Optic disc at the center of the field. Undilated pupil. Captured on a Topcon TRC-NW400 fundus camera. Color fundus image. 30° FOV. 2212x1661.
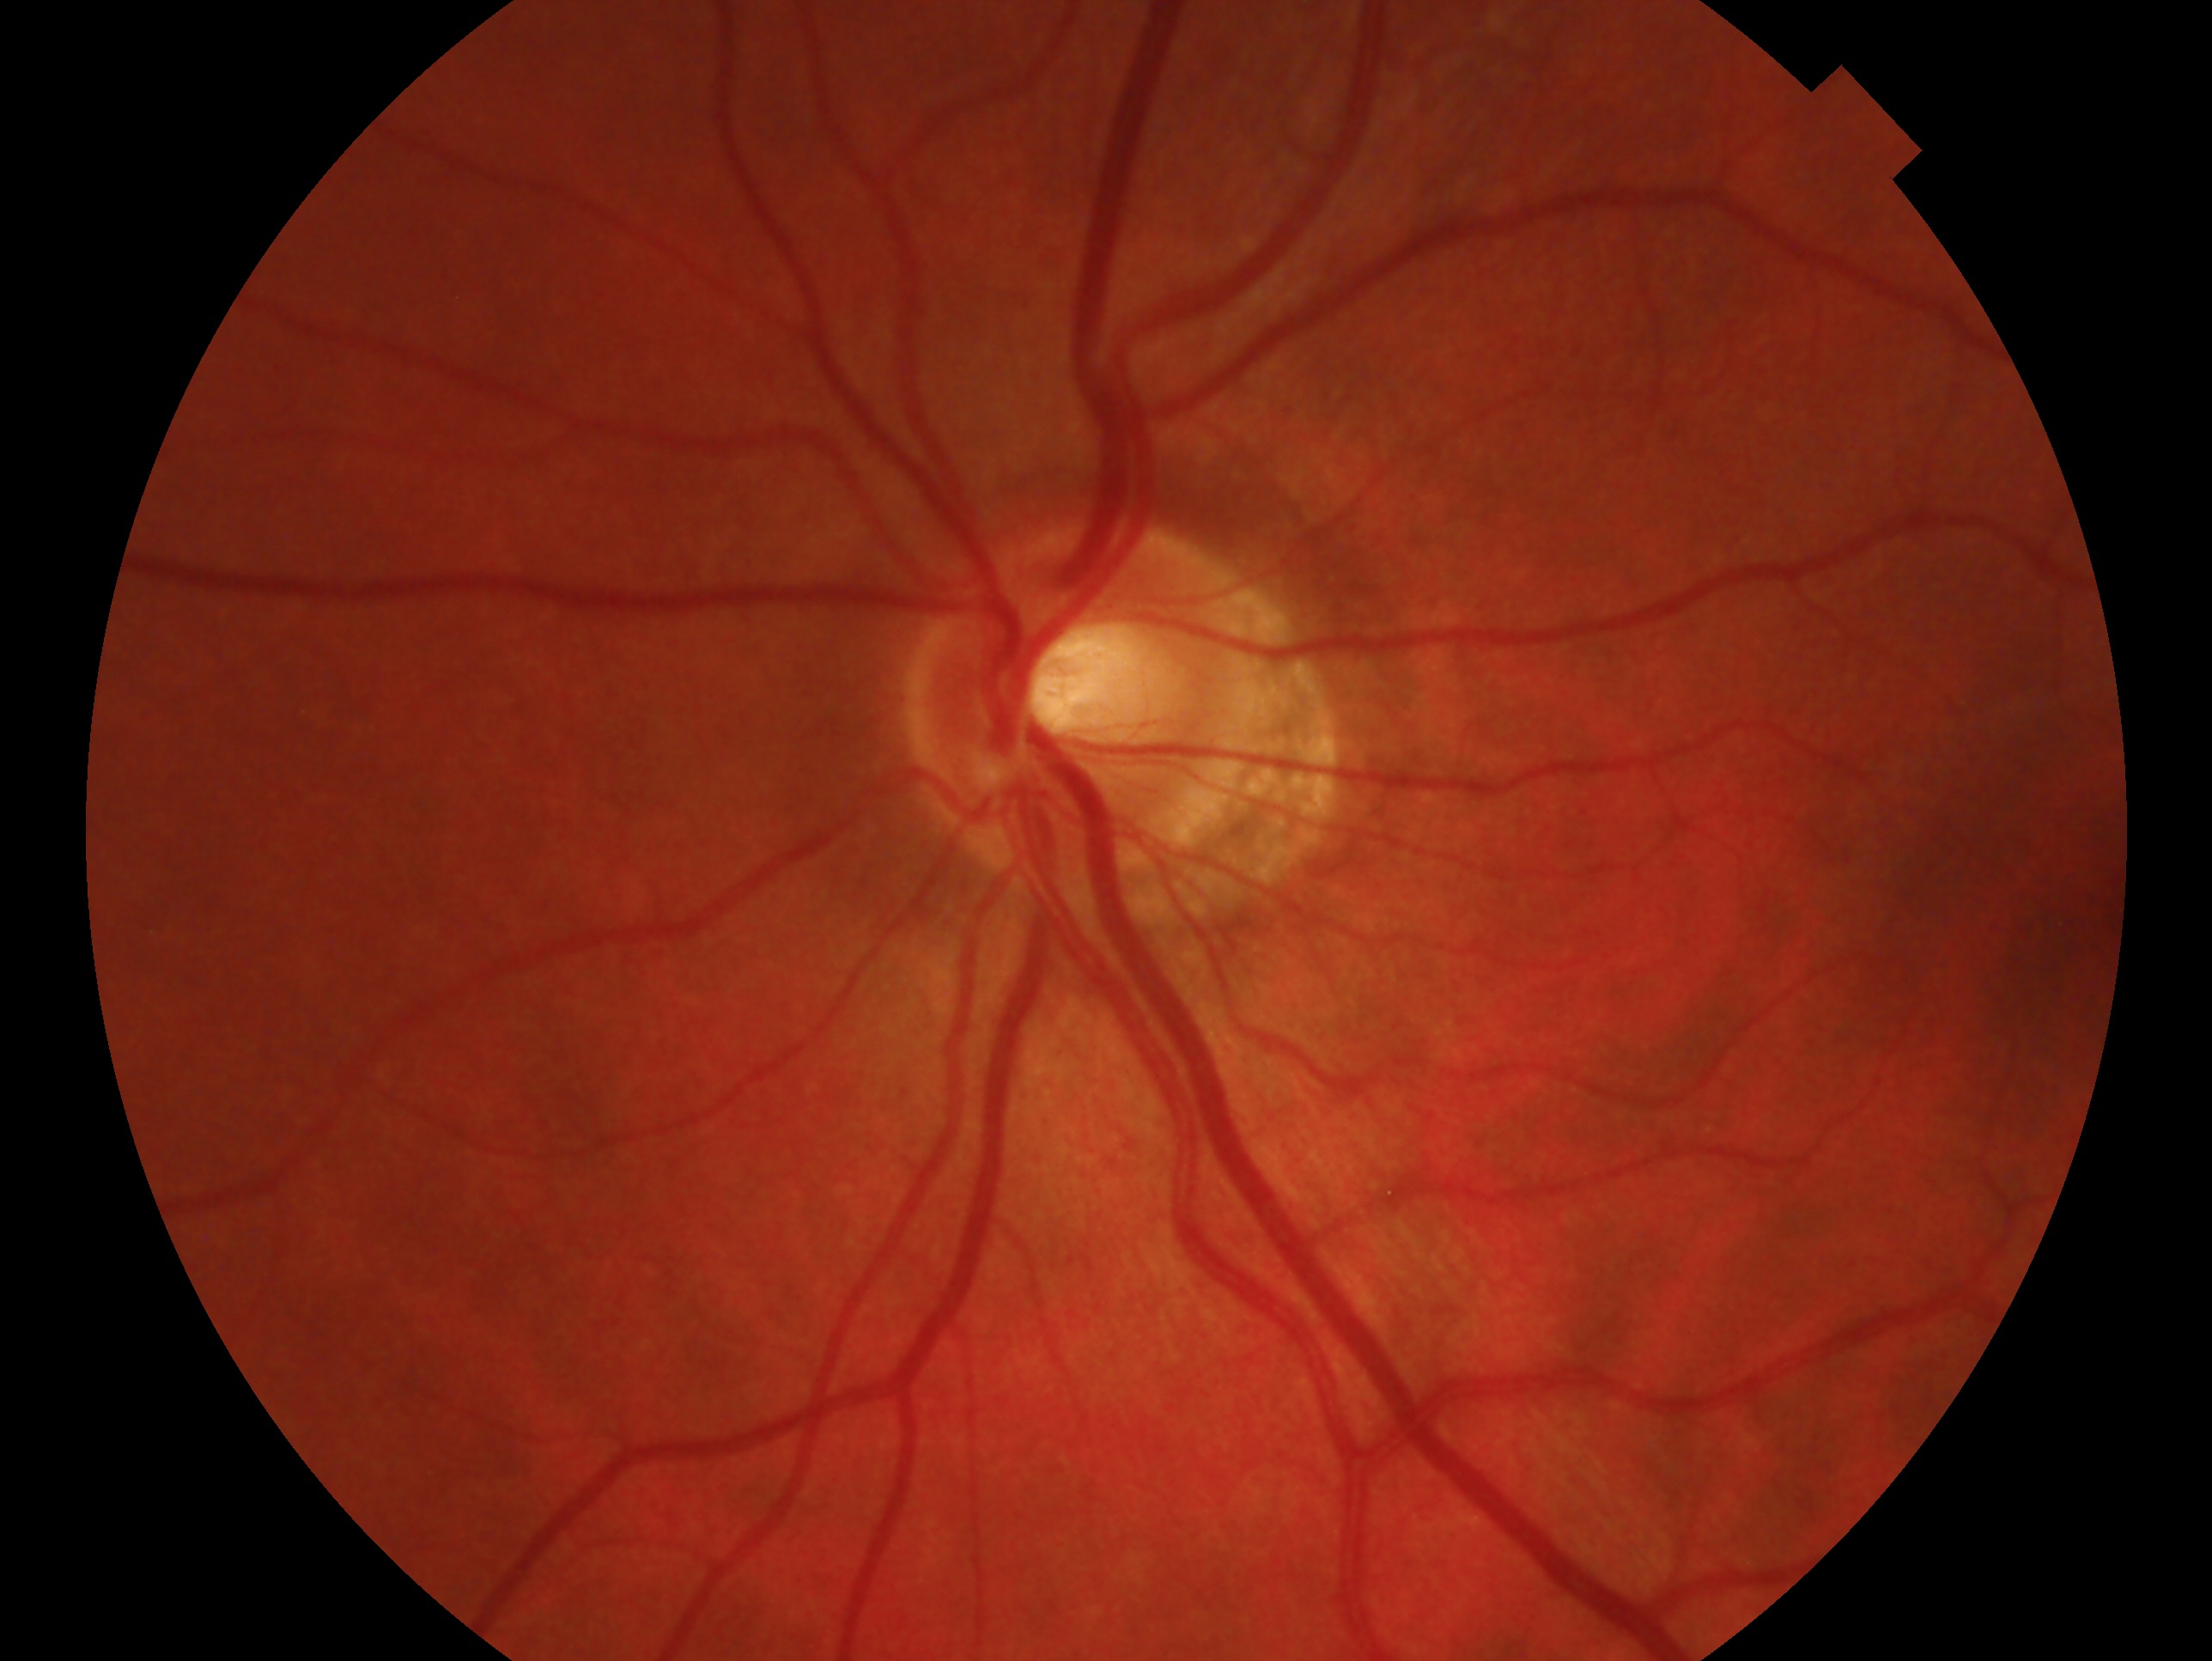
Findings:
– laterality: oculus sinister
– glaucoma assessment: no glaucomatous findings — no clinical evidence of glaucoma in this eye